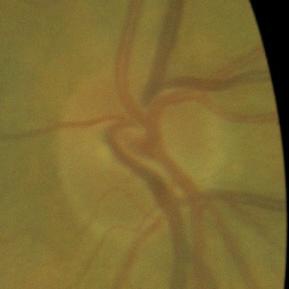 Glaucoma status = no evidence of glaucoma.